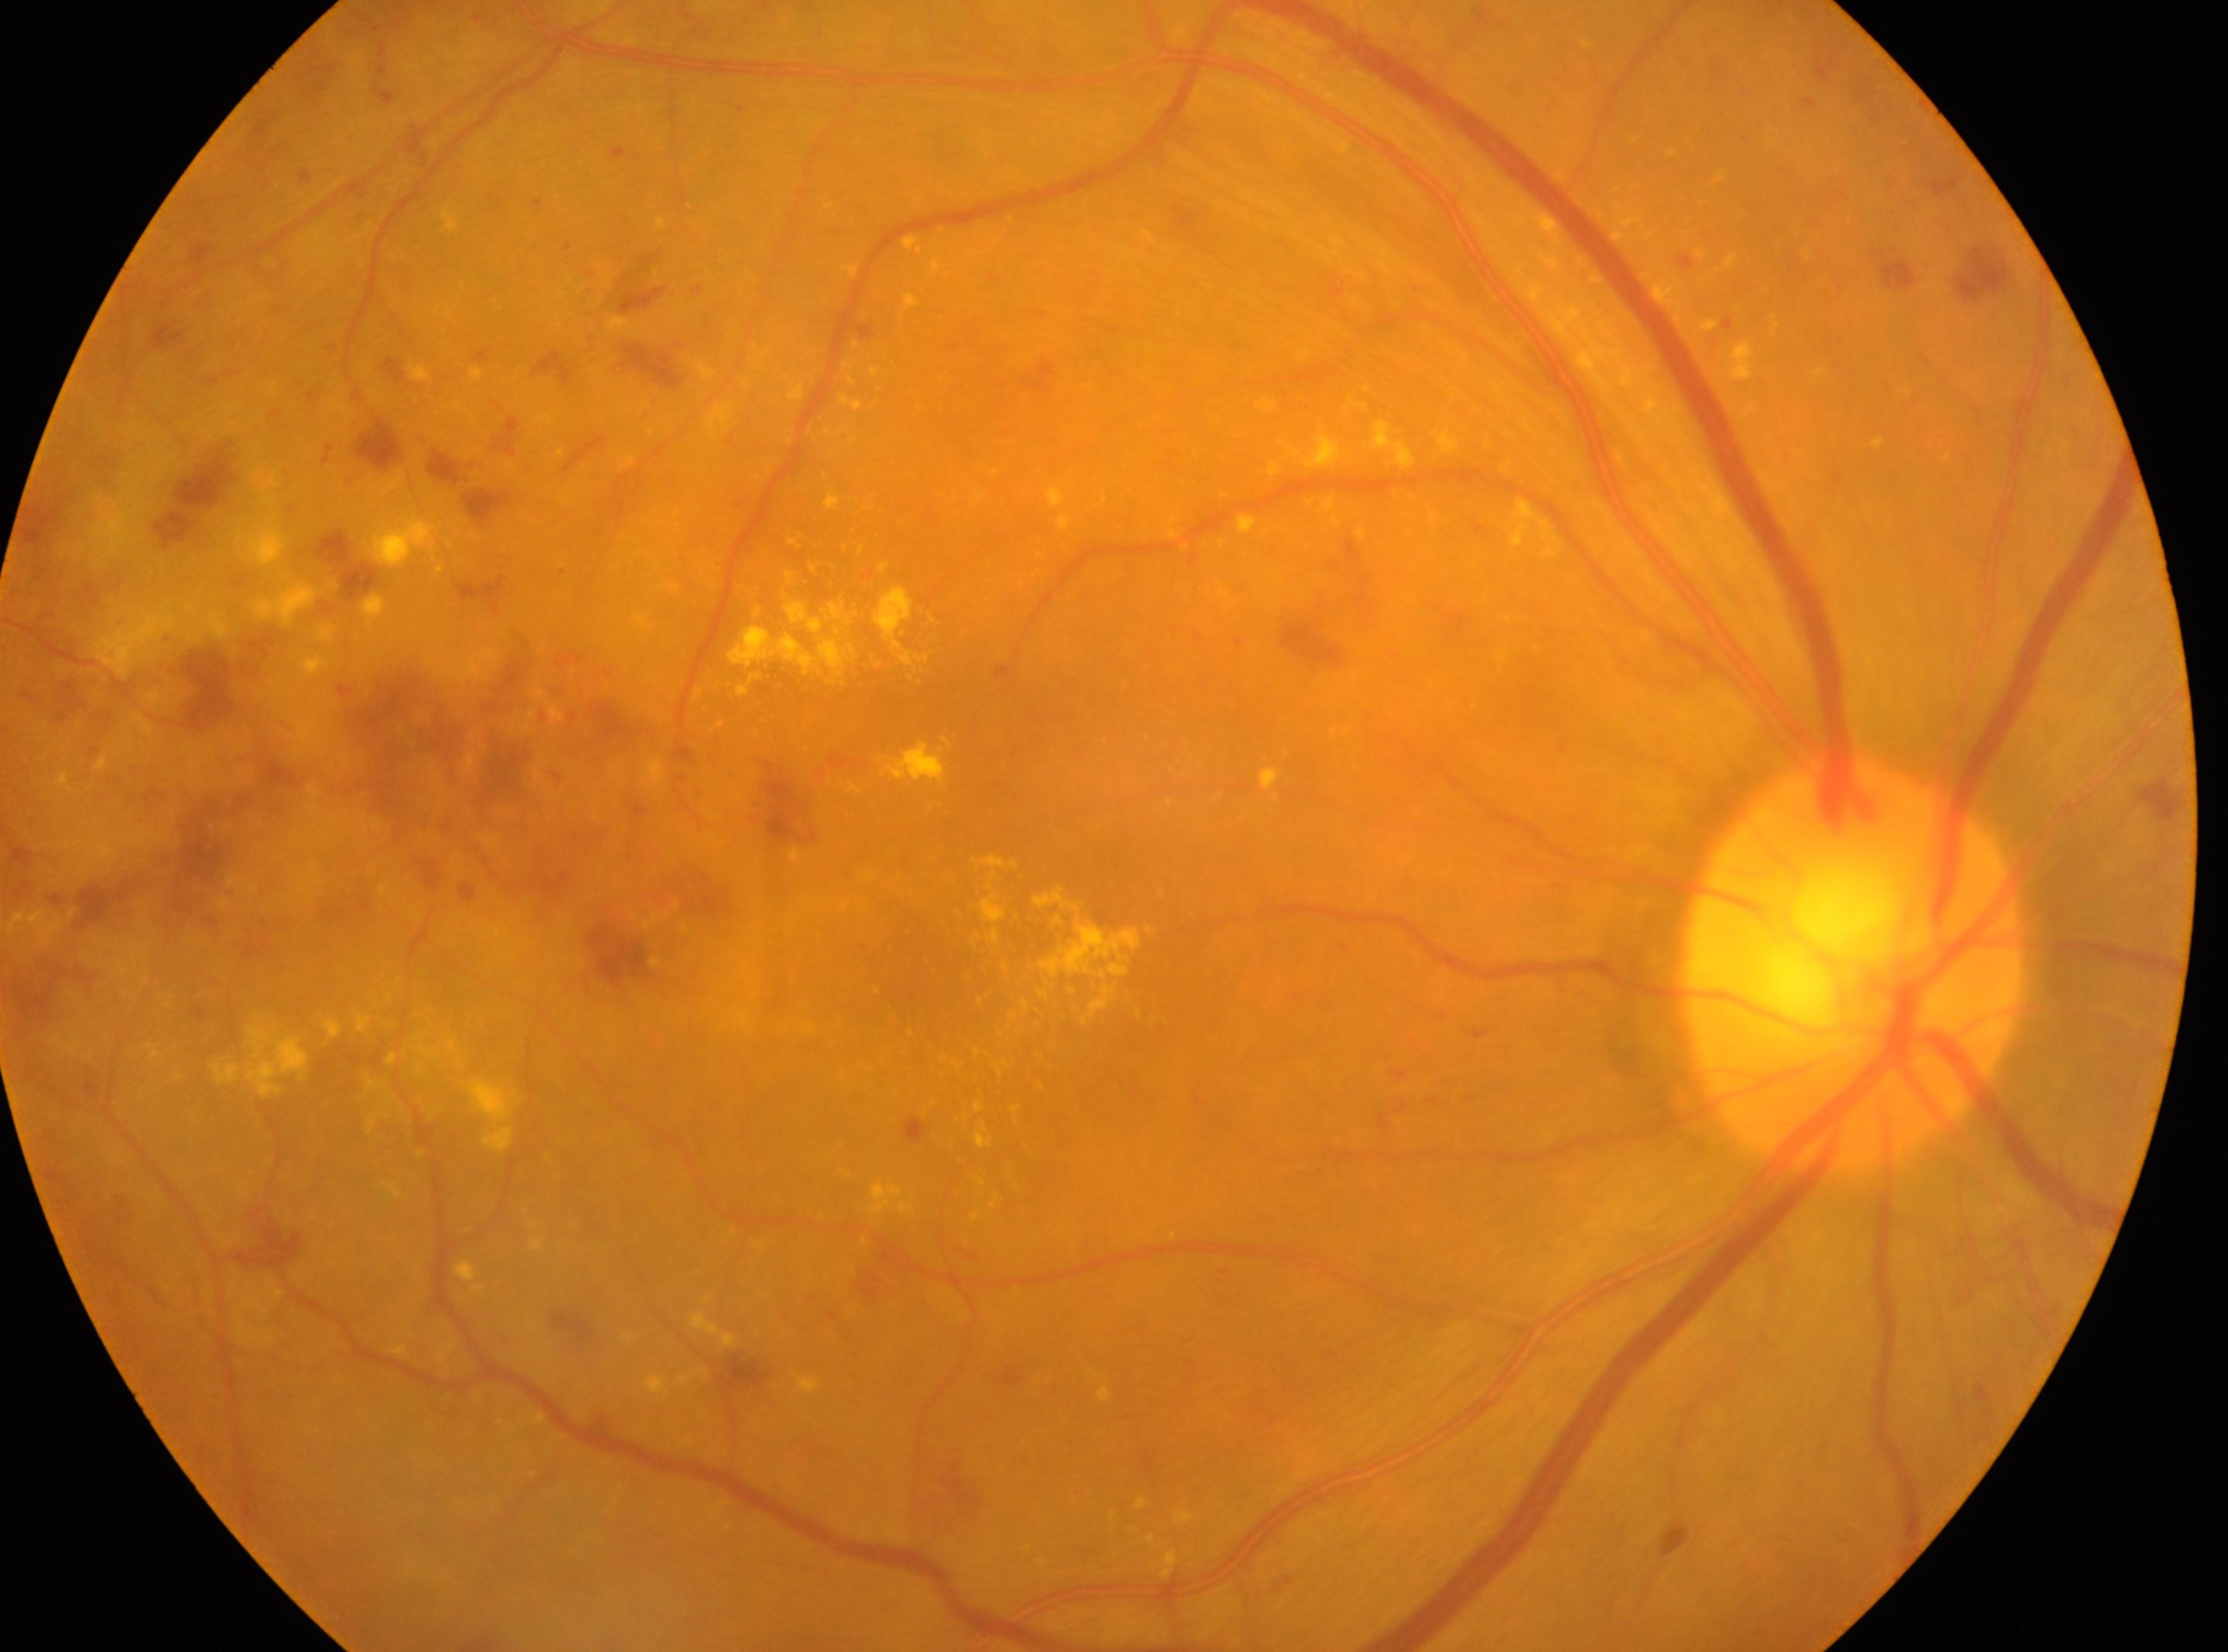

macula center = 925, 961
DR severity = grade 2
laterality = right
ONH = 1854, 964